FOV: 50 degrees: 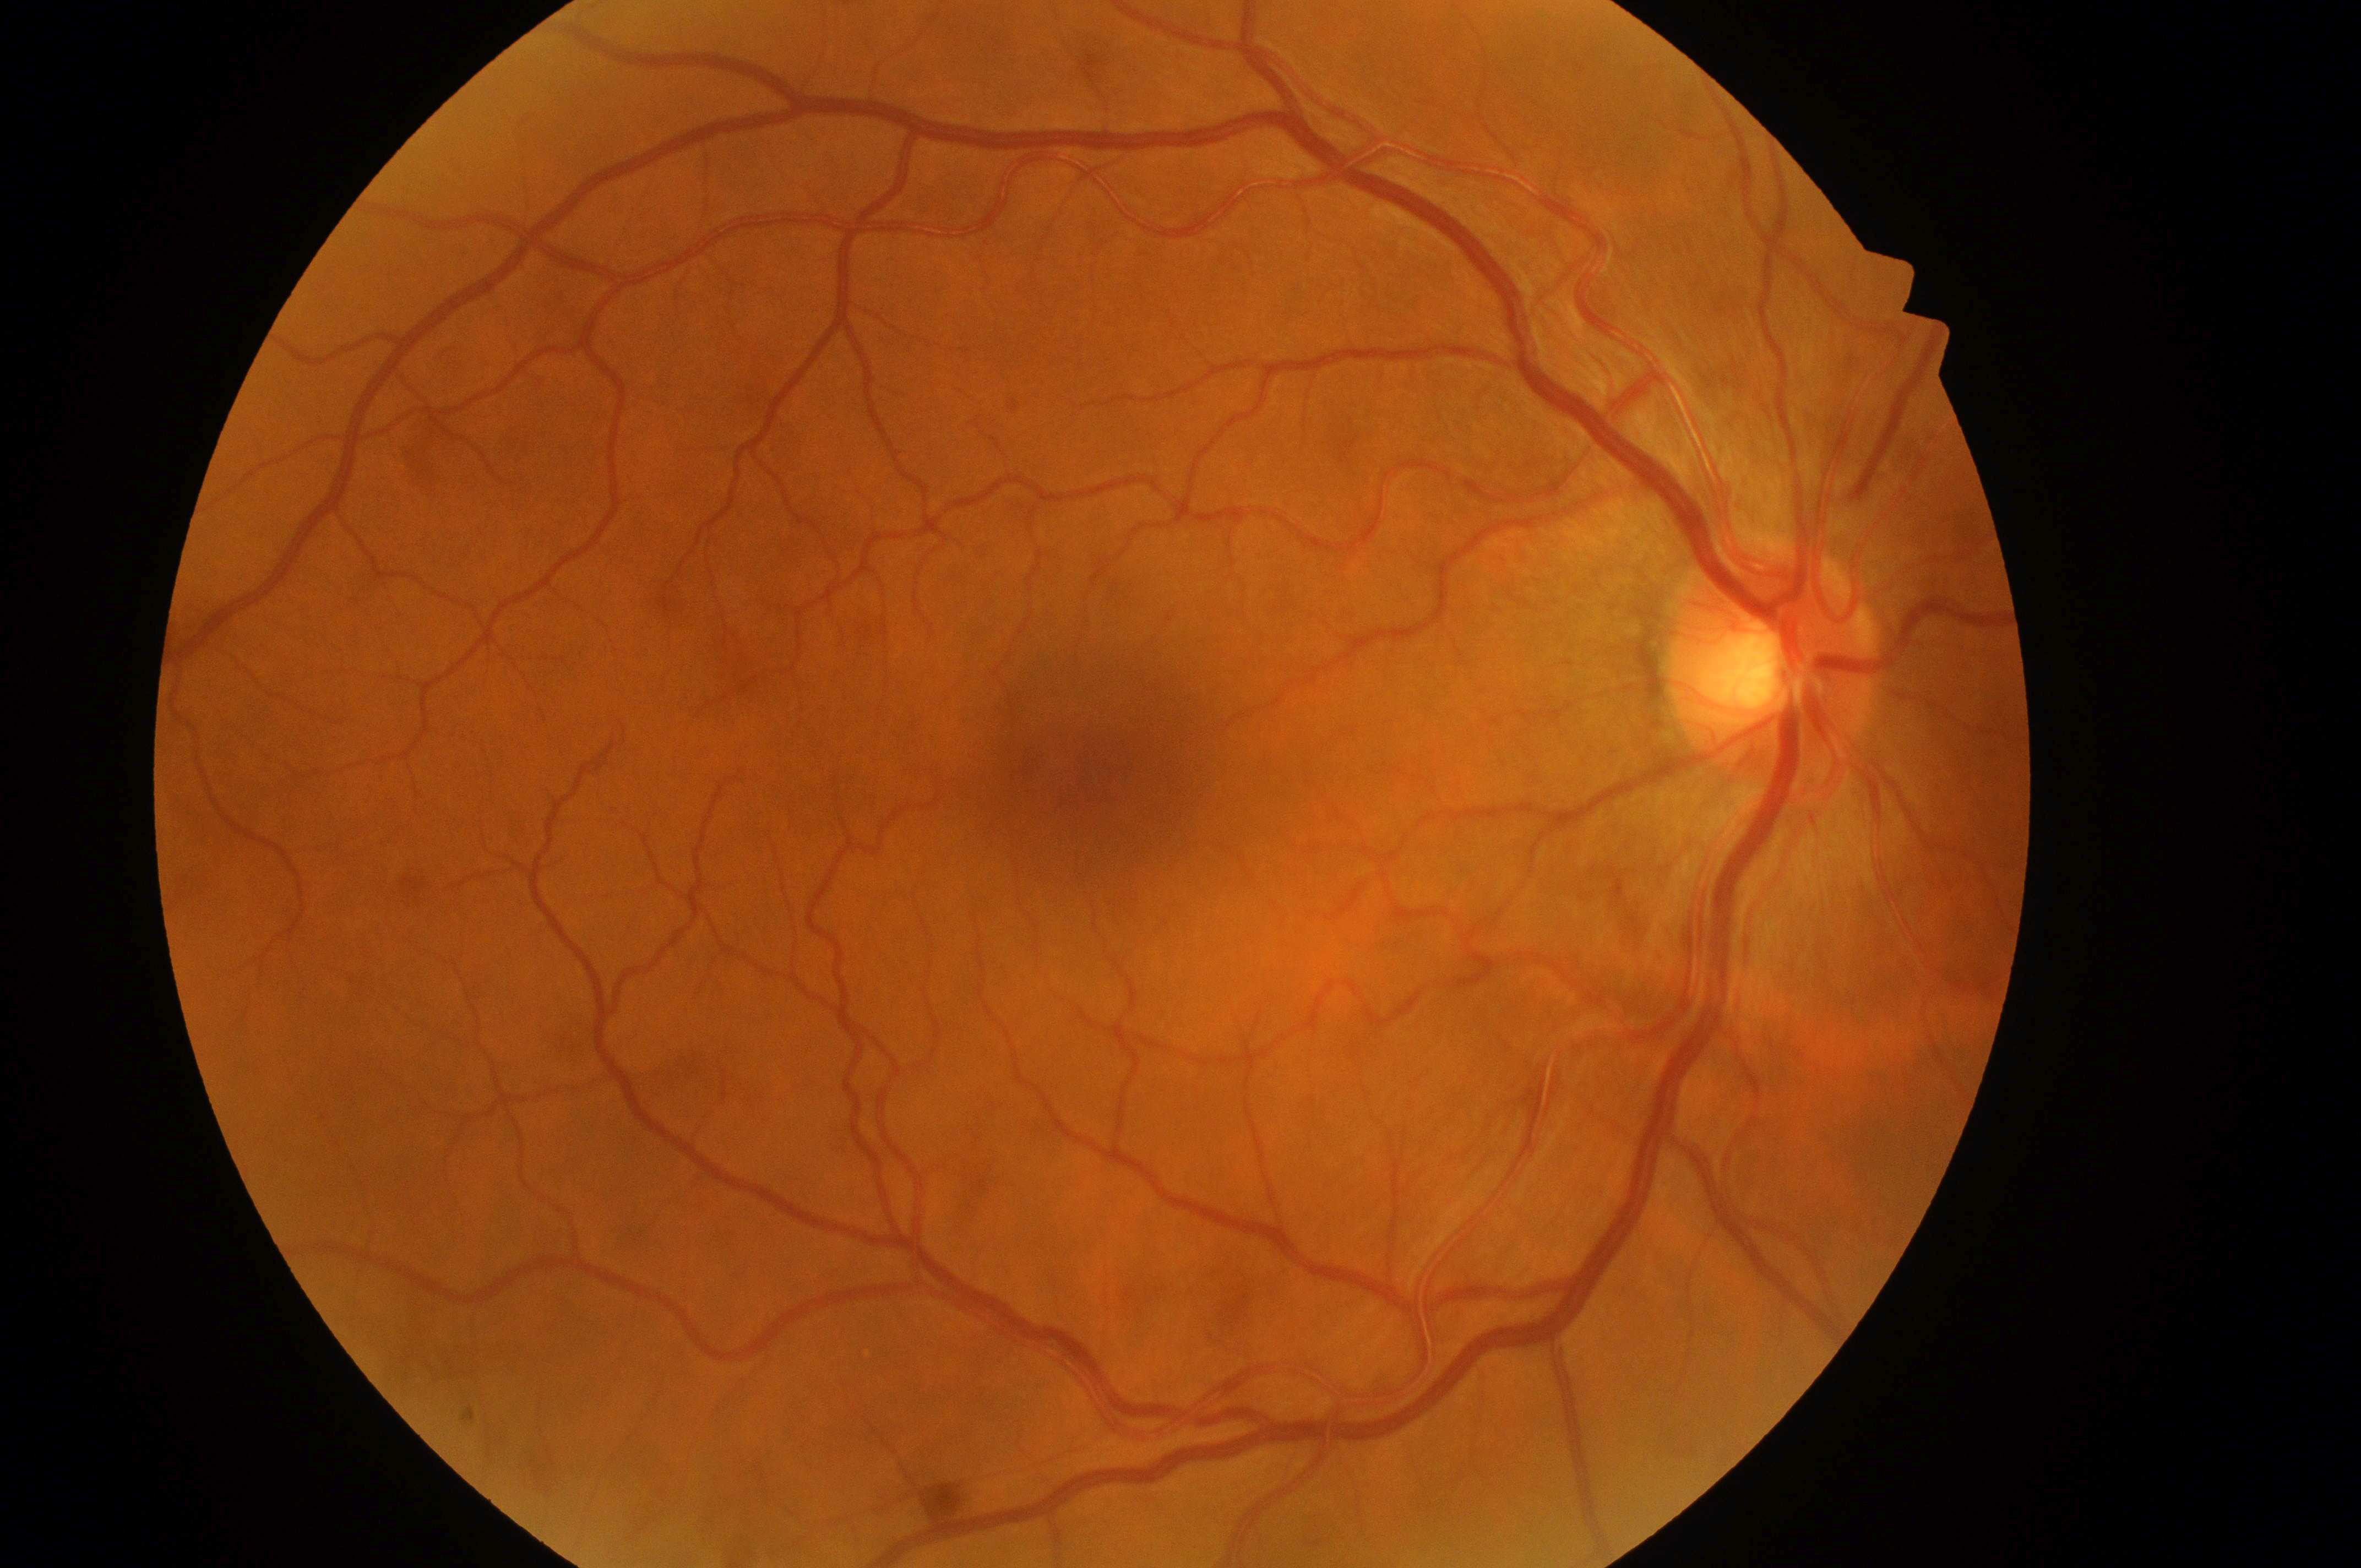
laterality = right eye | diabetic retinopathy = grade 0 | DR impression = No apparent diabetic retinopathy or macular edema | optic disc center = (x: 1764, y: 674) | foveal center = (x: 1087, y: 793) | risk of diabetic macular edema = 0.